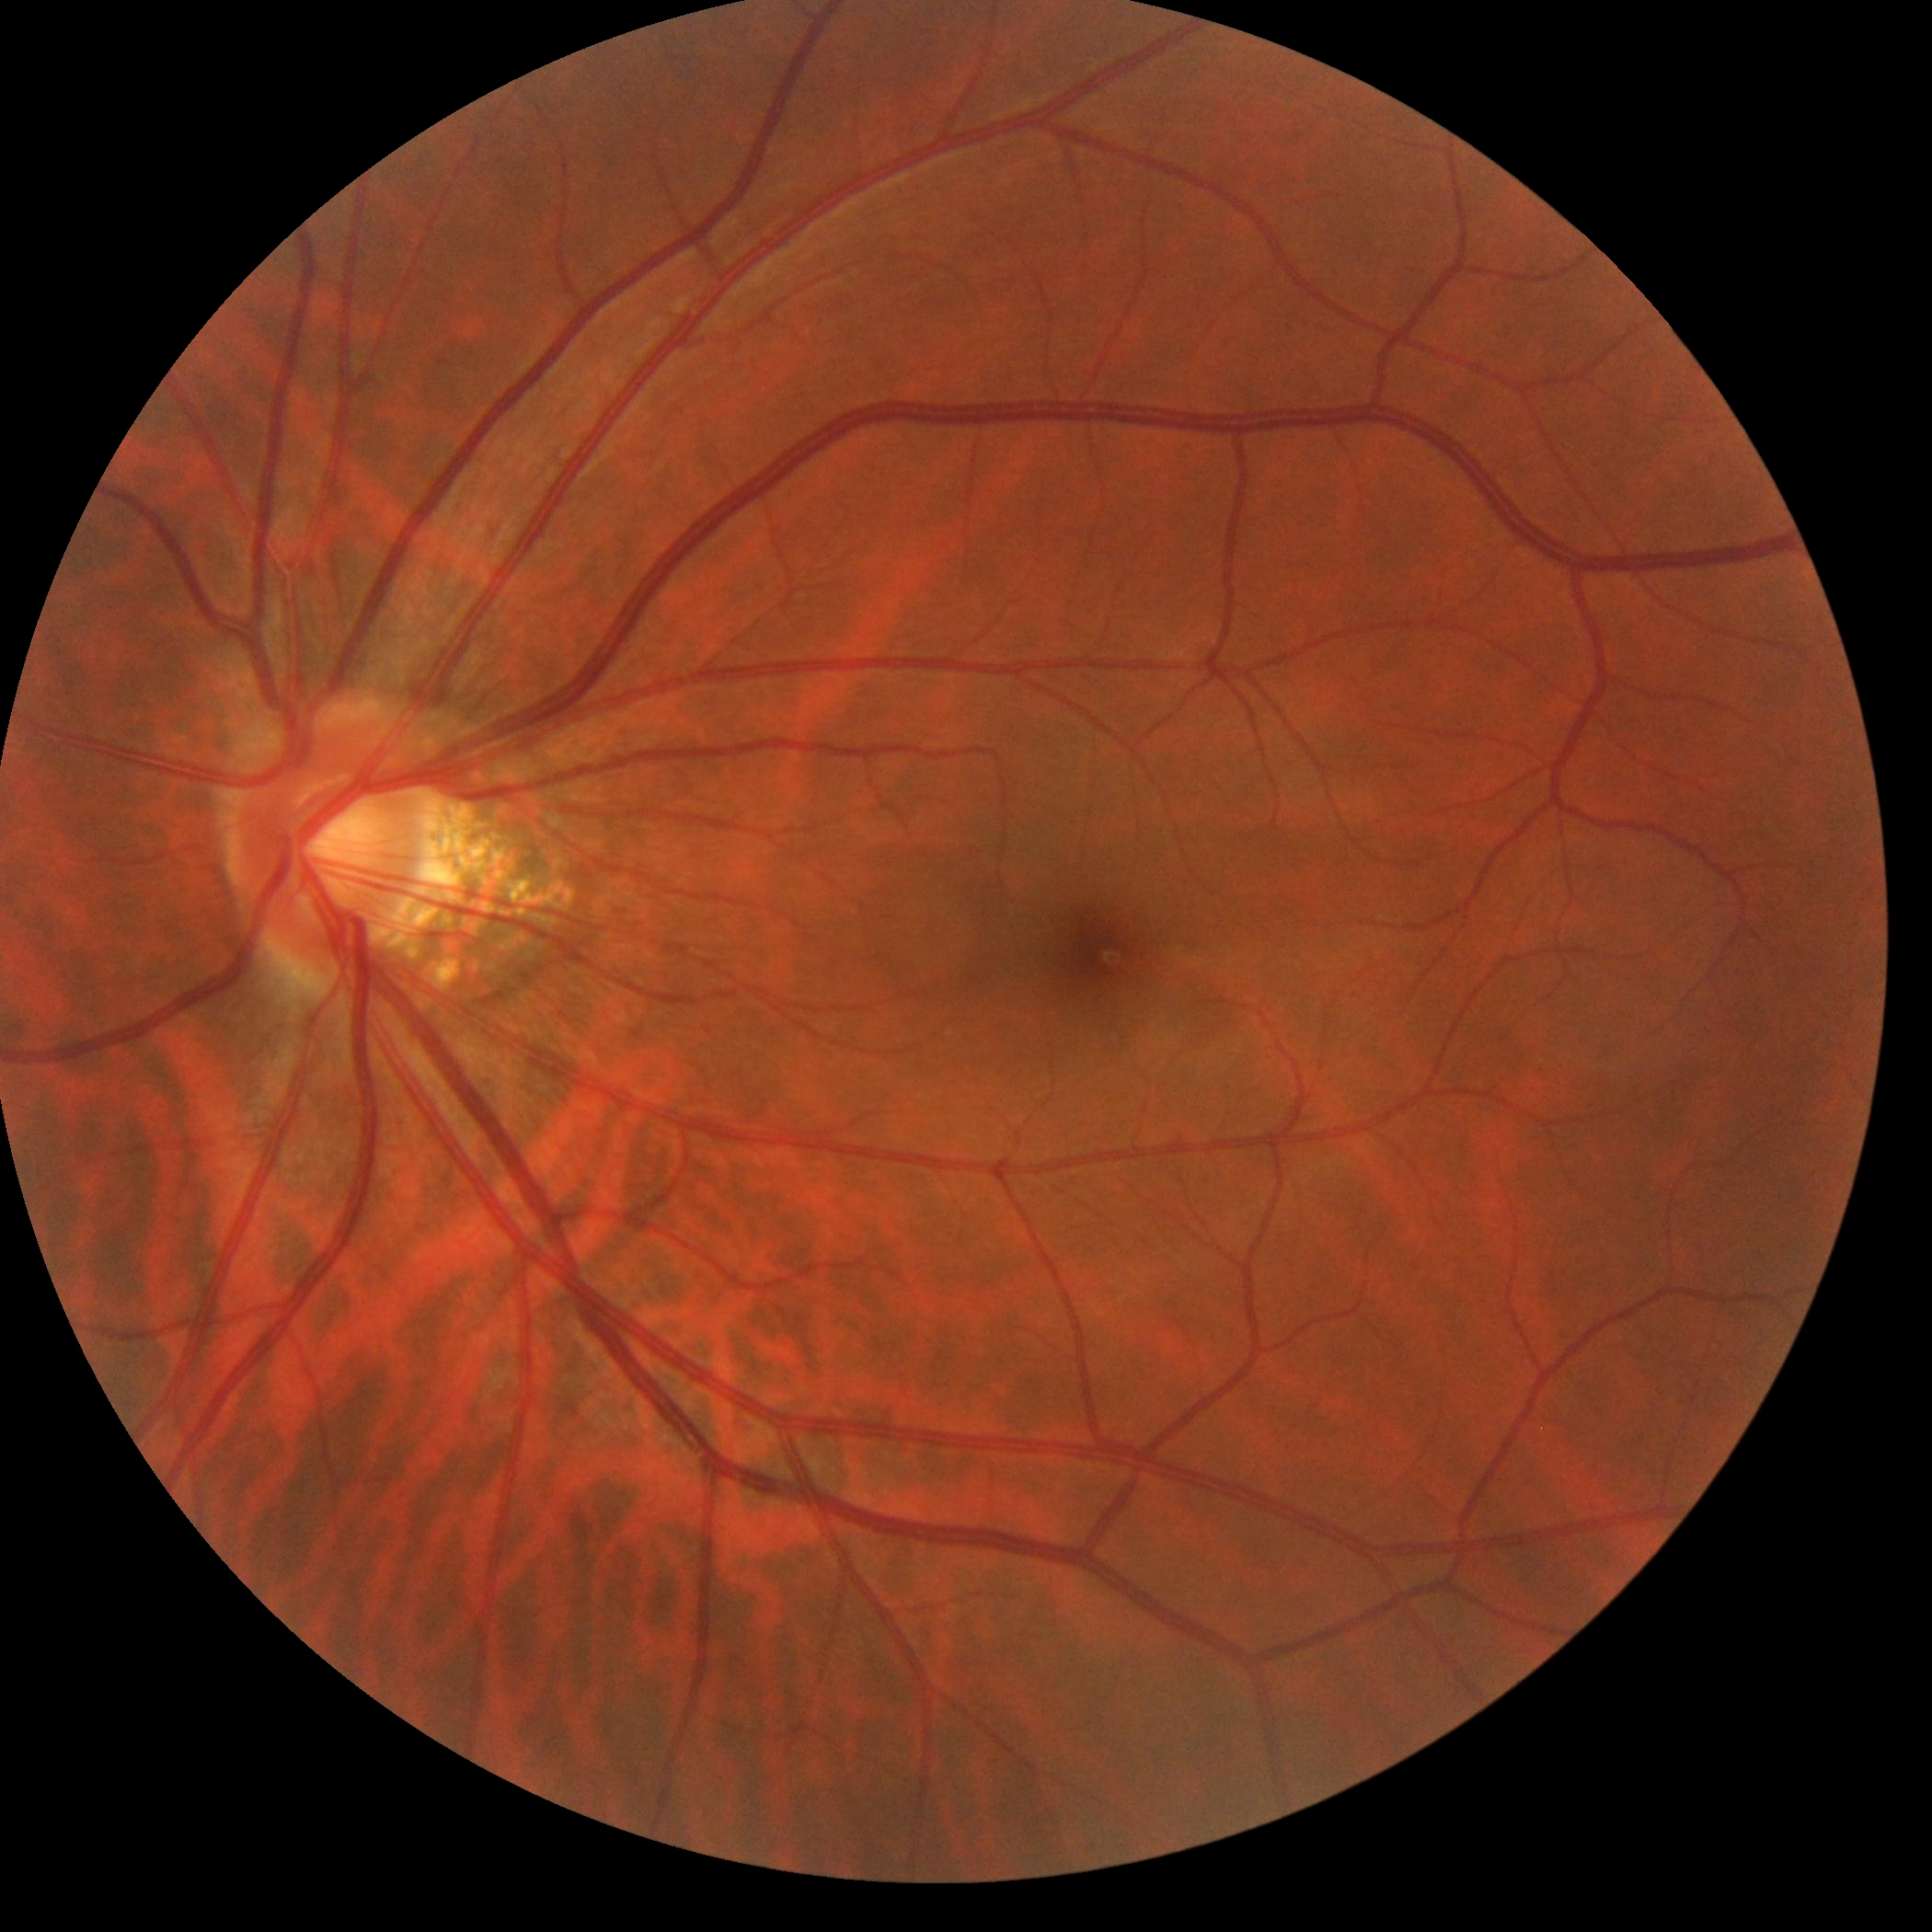 diabetic retinopathy (DR)=0; DR impression=no apparent DR.